Acquired with a Nidek AFC-330: 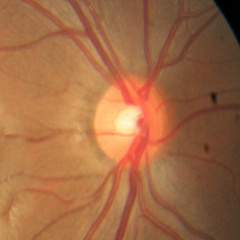 Impression: no glaucomatous changes.